848 x 848 pixels. Color fundus photograph — 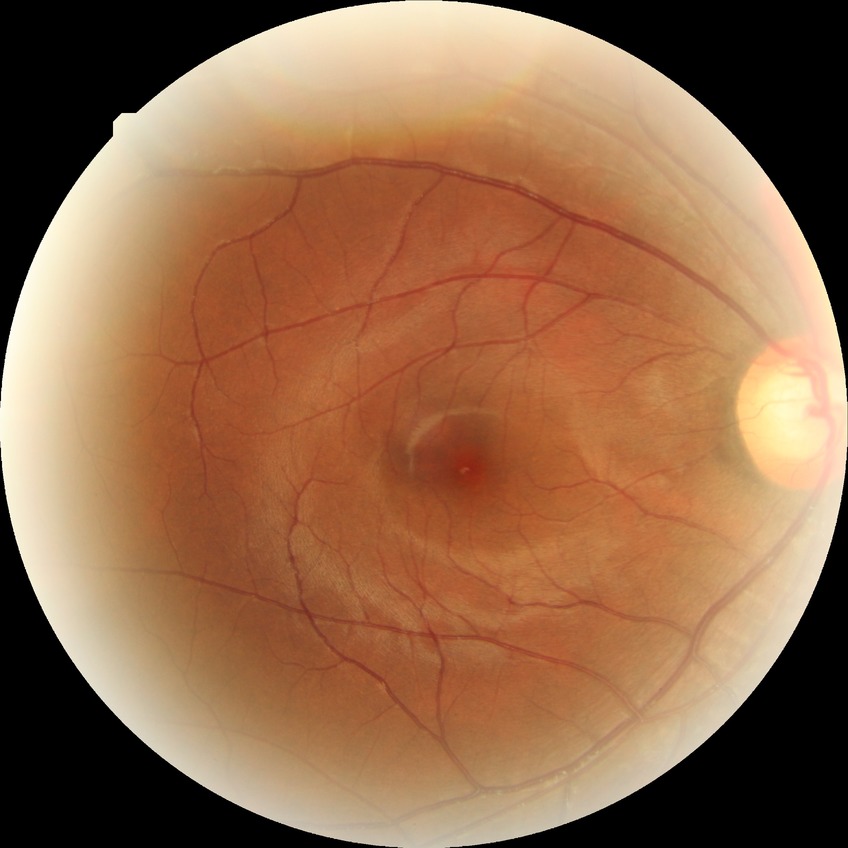
DR grade: NDR. No signs of diabetic retinopathy.